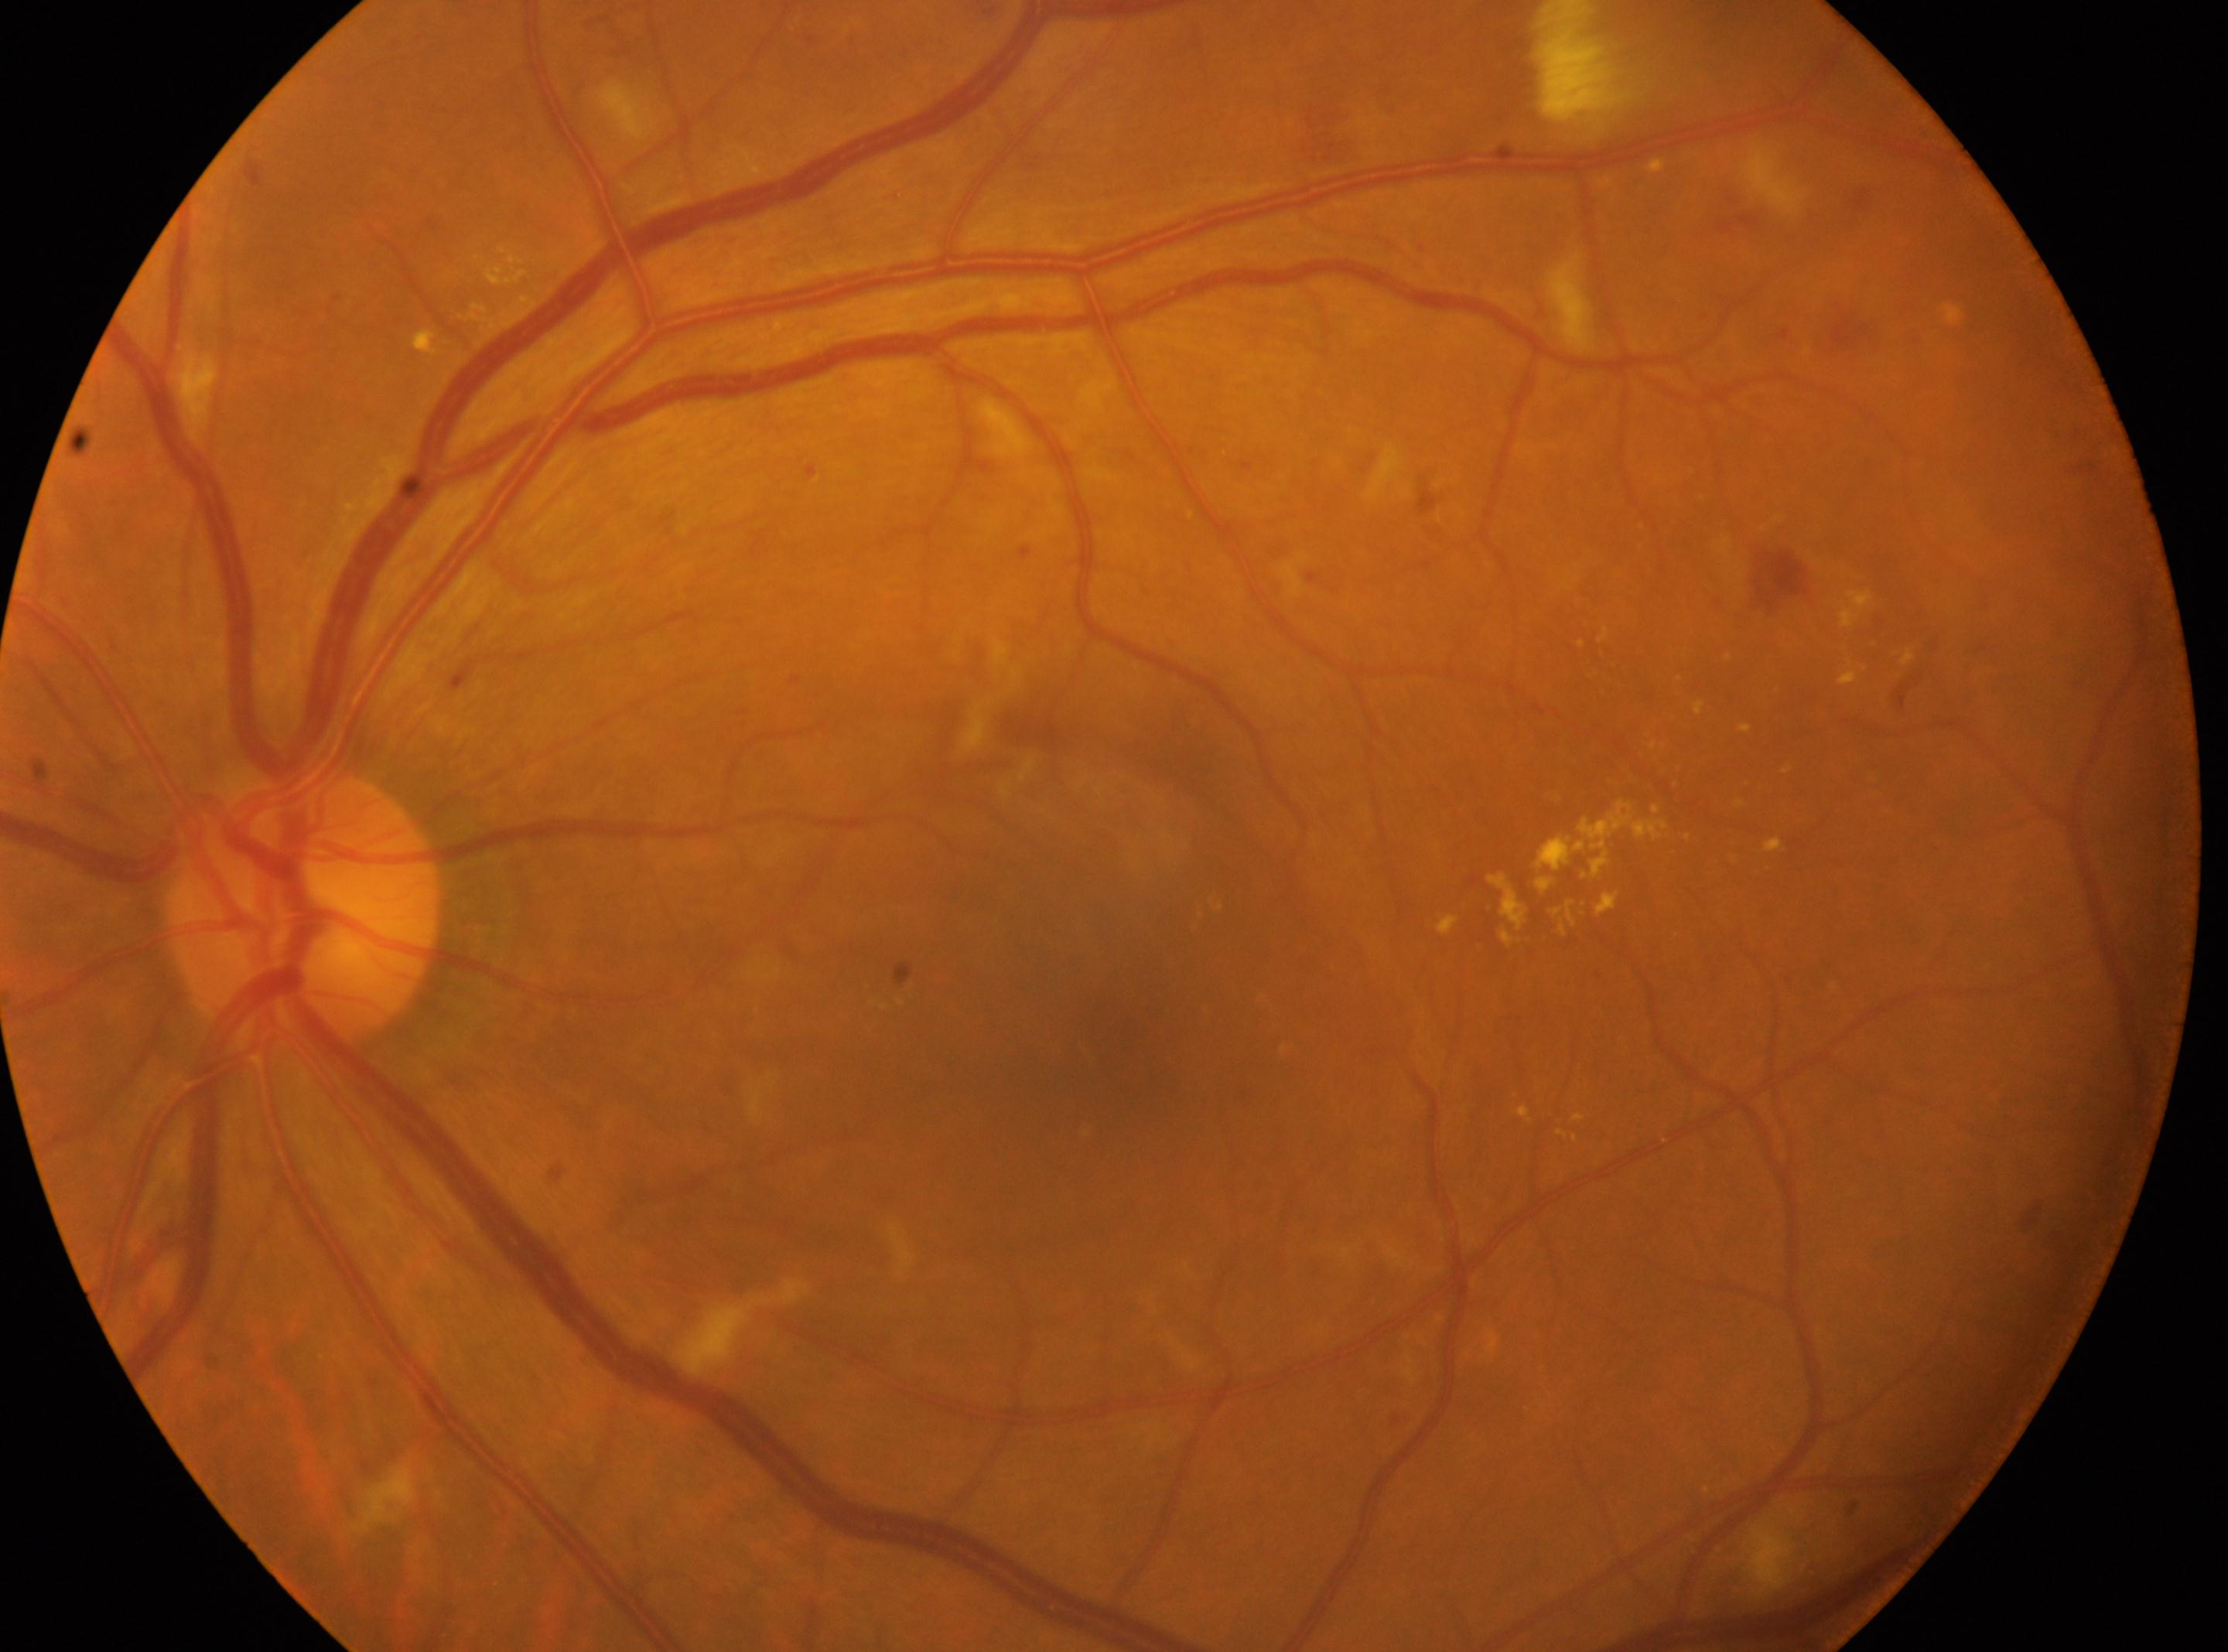

Diabetic retinopathy (DR) is 2/4 — more than just microaneurysms but less than severe NPDR. The ONH is at (x: 302, y: 911). This is the left eye. Foveal center located at (x: 1103, y: 1041).